Wide-field fundus image from infant ROP screening · camera: Clarity RetCam 3 (130° FOV): 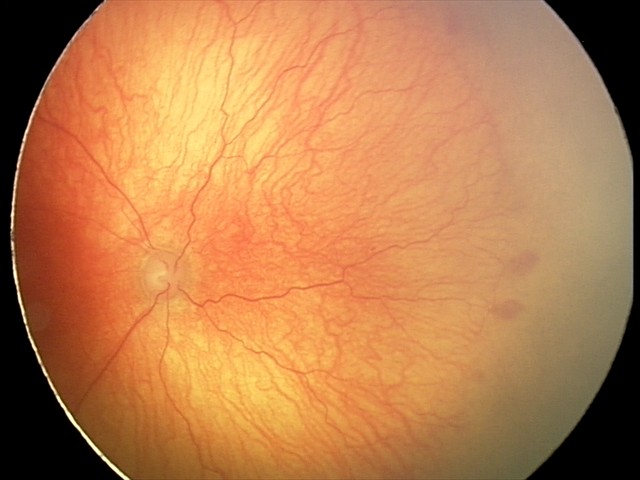

Examination diagnosed as aggressive retinopathy of prematurity (A-ROP) — rapidly progressive severe ROP with prominent plus disease, often without classic stage progression.